Wide-field contact fundus photograph of an infant.
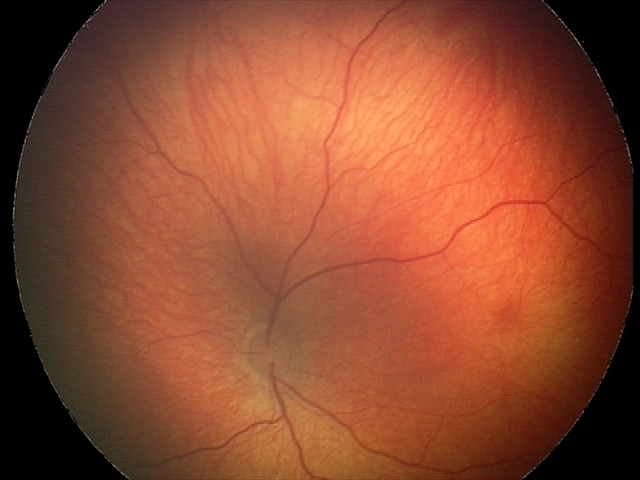

Assessment = retinal hemorrhages.